Wide-field contact fundus photograph of an infant. Captured with the Phoenix ICON (100° field of view):
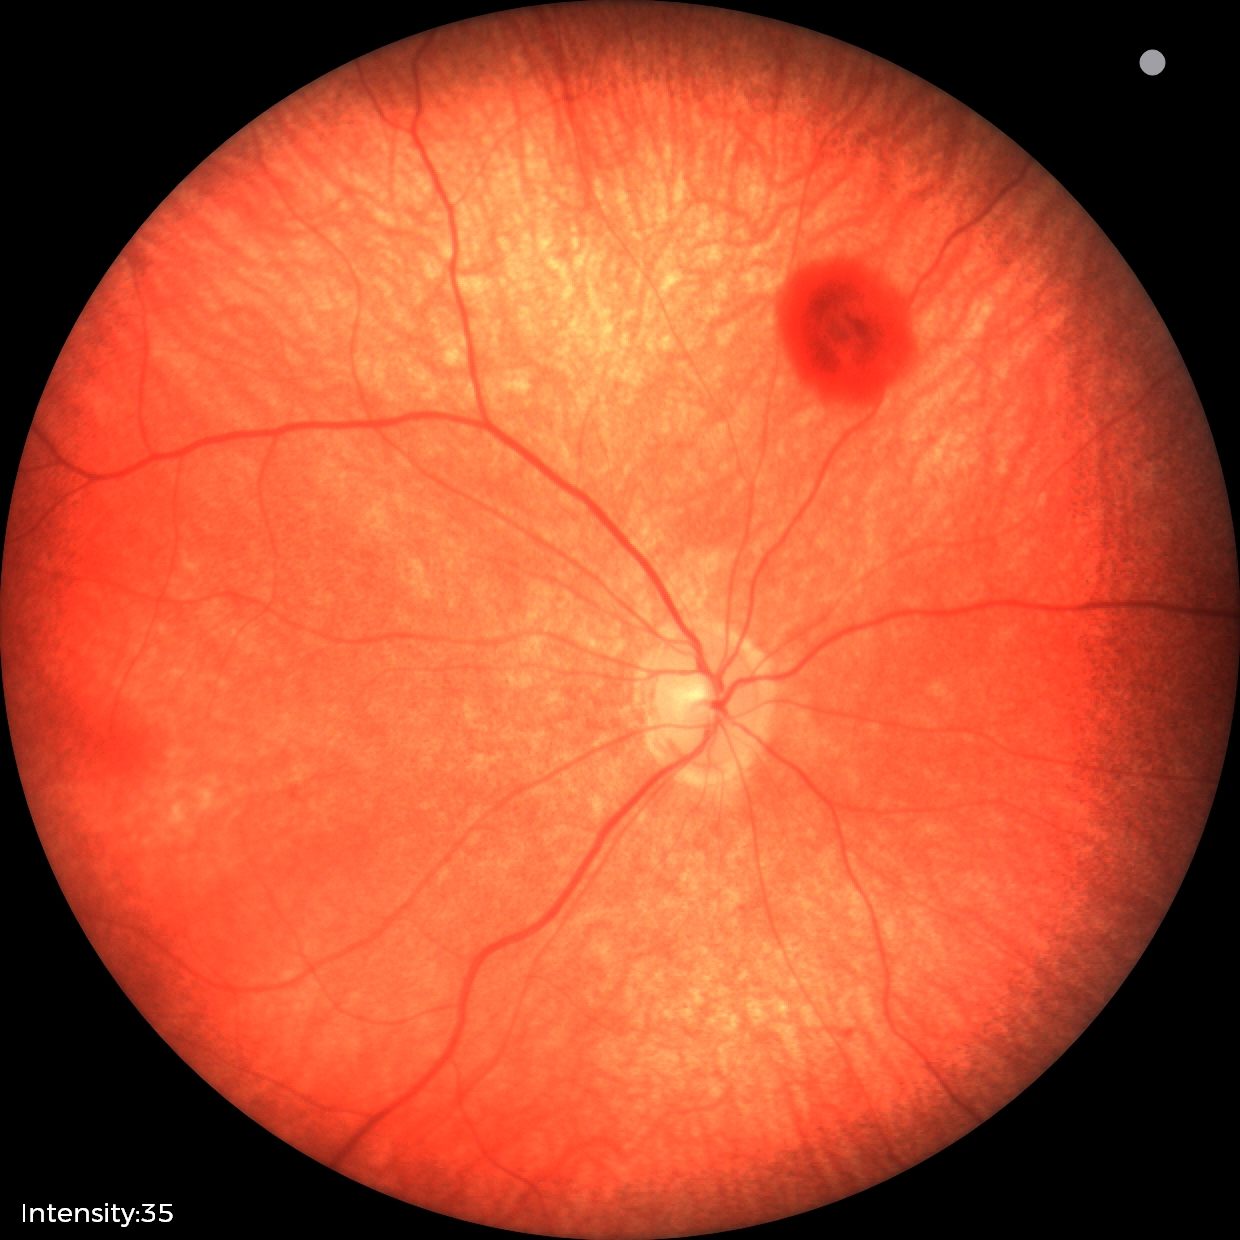

Impression: retinal hemorrhages.